FOV: 45 degrees
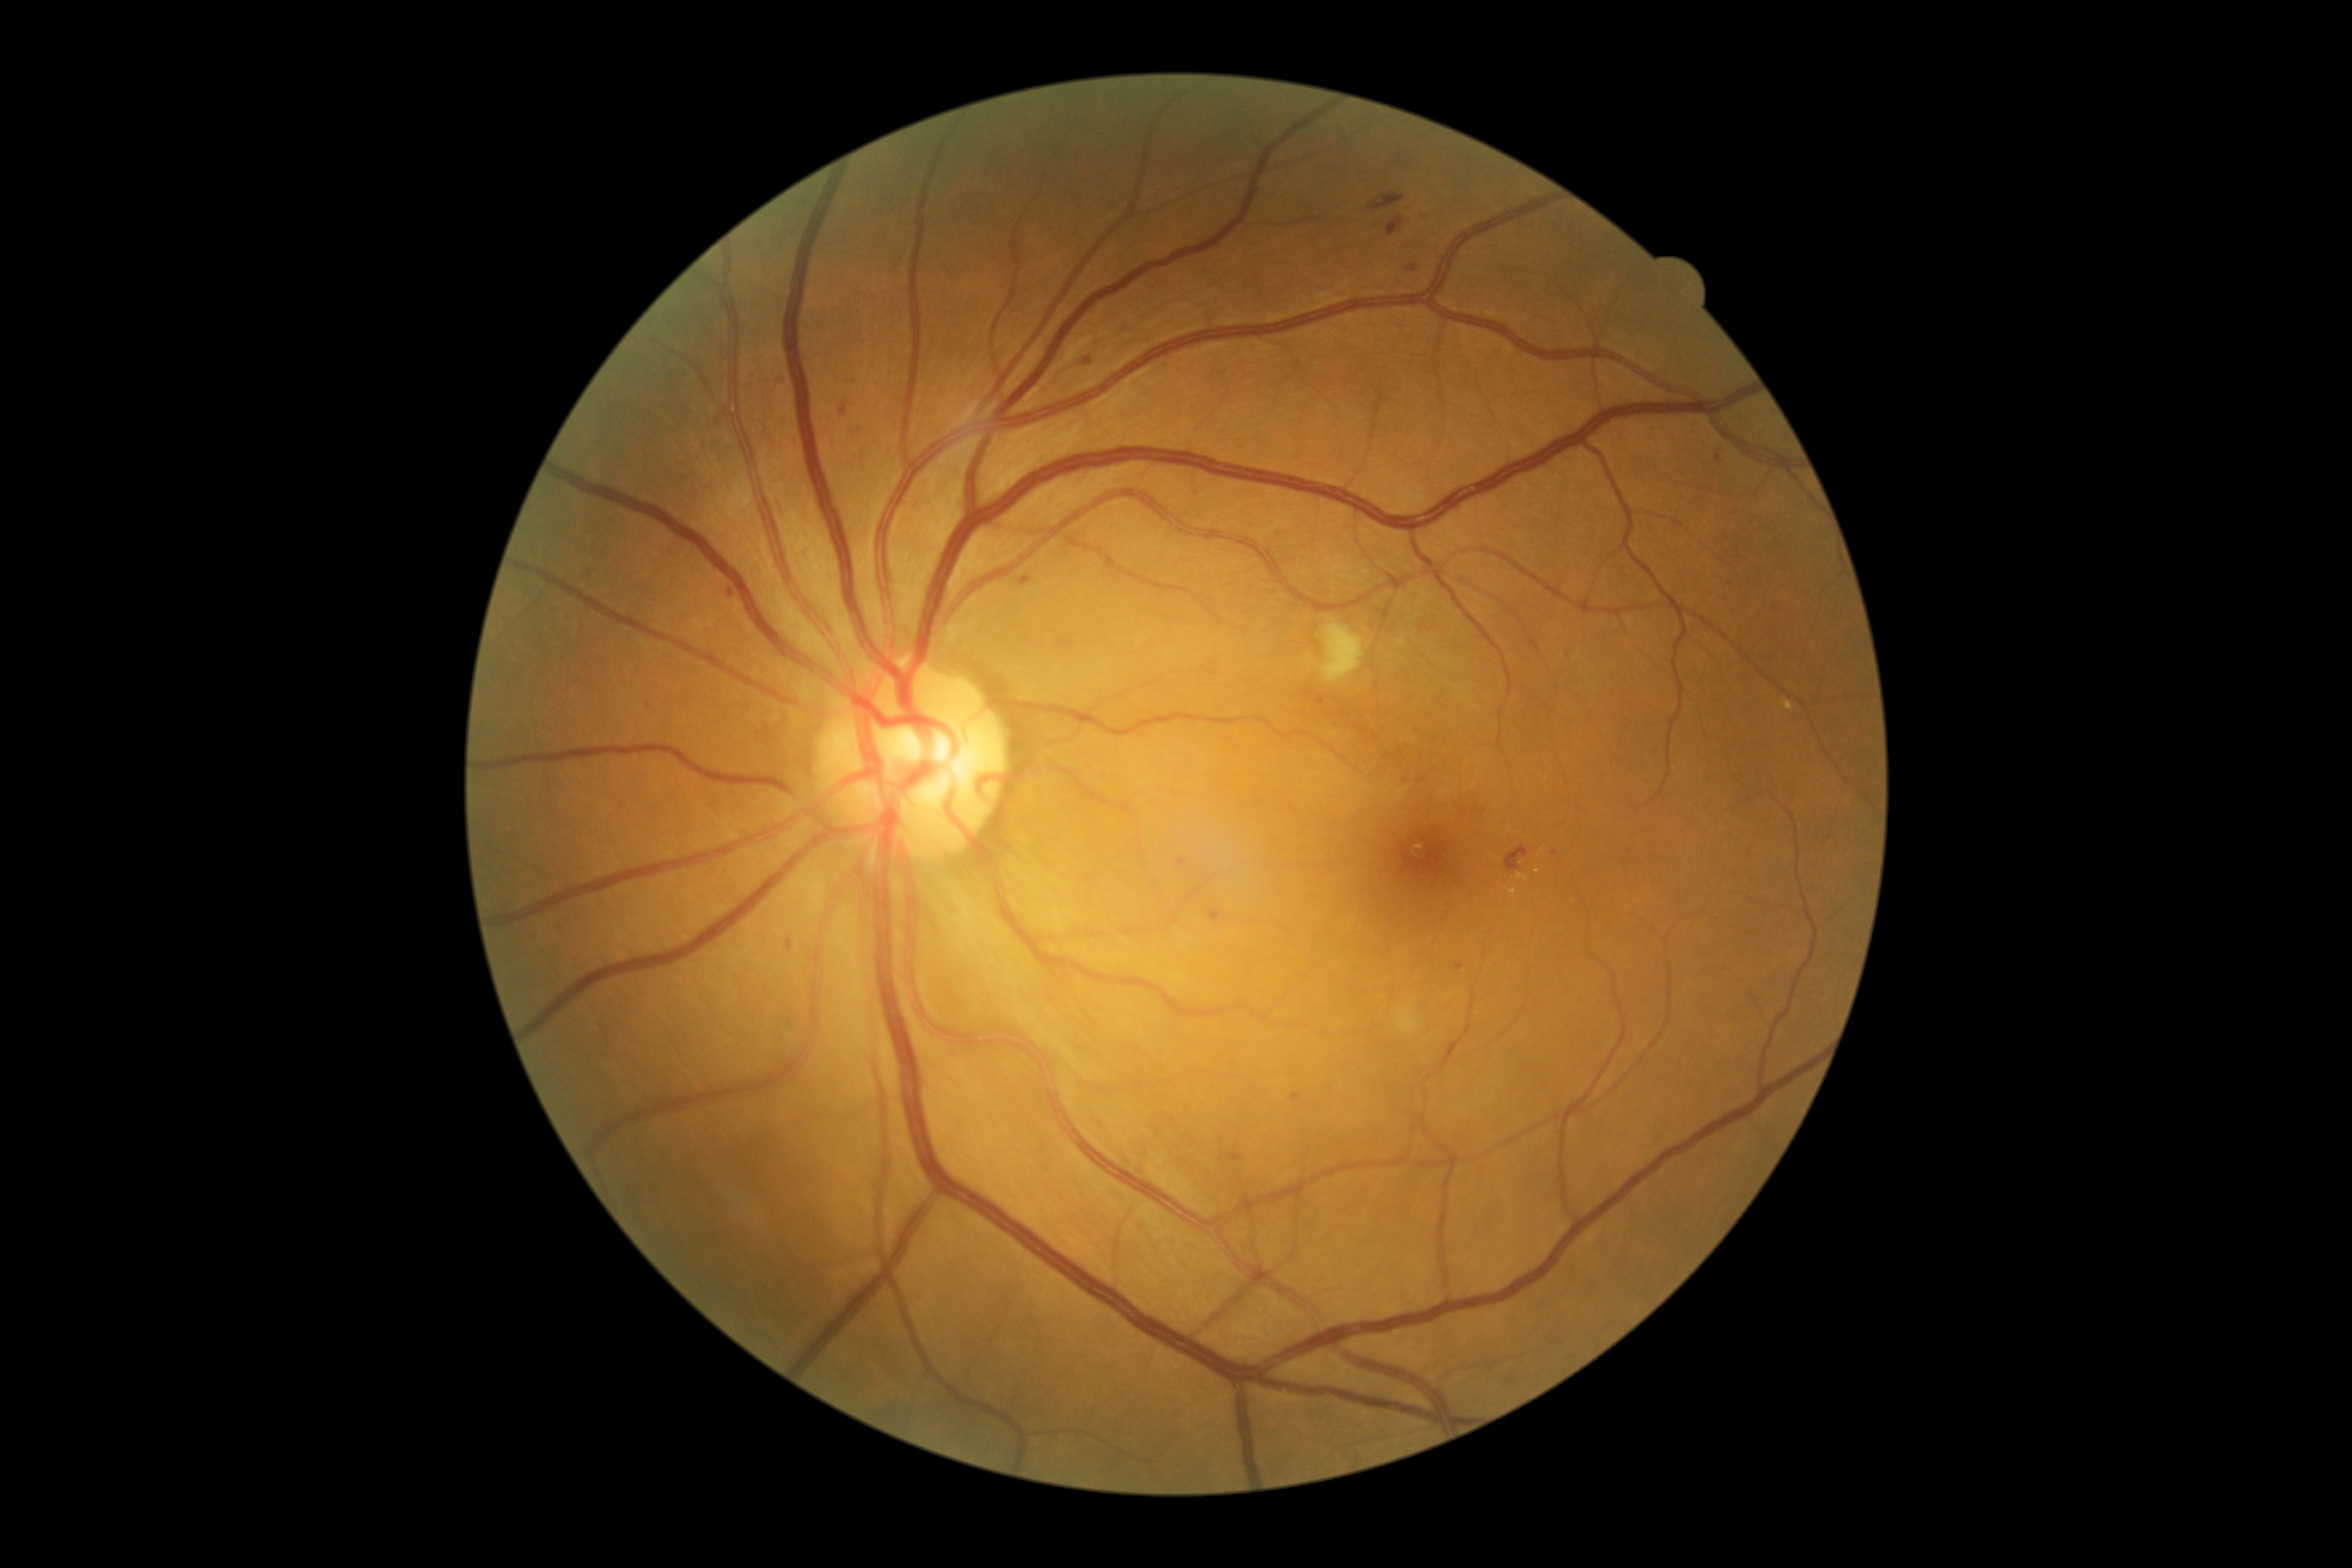
Diabetic retinopathy (DR): grade 2 (moderate NPDR)
Representative lesions:
- hard exudates (EXs) (partial): BBox(1509, 888, 1517, 895) | BBox(1517, 873, 1528, 881) | BBox(1784, 701, 1794, 713)
- Small EXs near 1538, 872
- soft exudates (SEs): BBox(1320, 622, 1366, 683) | BBox(1397, 1003, 1421, 1034)
- hemorrhages (HEs): BBox(1368, 193, 1404, 211) | BBox(1507, 847, 1529, 873) | BBox(1388, 219, 1404, 236) | BBox(1409, 266, 1419, 273)
- Small HEs near 1089, 361
- microaneurysms (MAs) (partial): BBox(1421, 217, 1430, 223) | BBox(1230, 1155, 1244, 1163) | BBox(728, 589, 735, 597) | BBox(842, 405, 848, 415) | BBox(1208, 910, 1222, 922) | BBox(1316, 697, 1326, 706) | BBox(1292, 1093, 1302, 1101) | BBox(1455, 964, 1464, 971) | BBox(787, 940, 793, 952) | BBox(1179, 859, 1187, 867) | BBox(1019, 575, 1031, 587)
- Small MAs near 1483, 812 | 860, 430 | 1422, 780 | 1555, 855 | 671, 554 | 1719, 458 | 783, 380 | 649, 707